Nonmydriatic
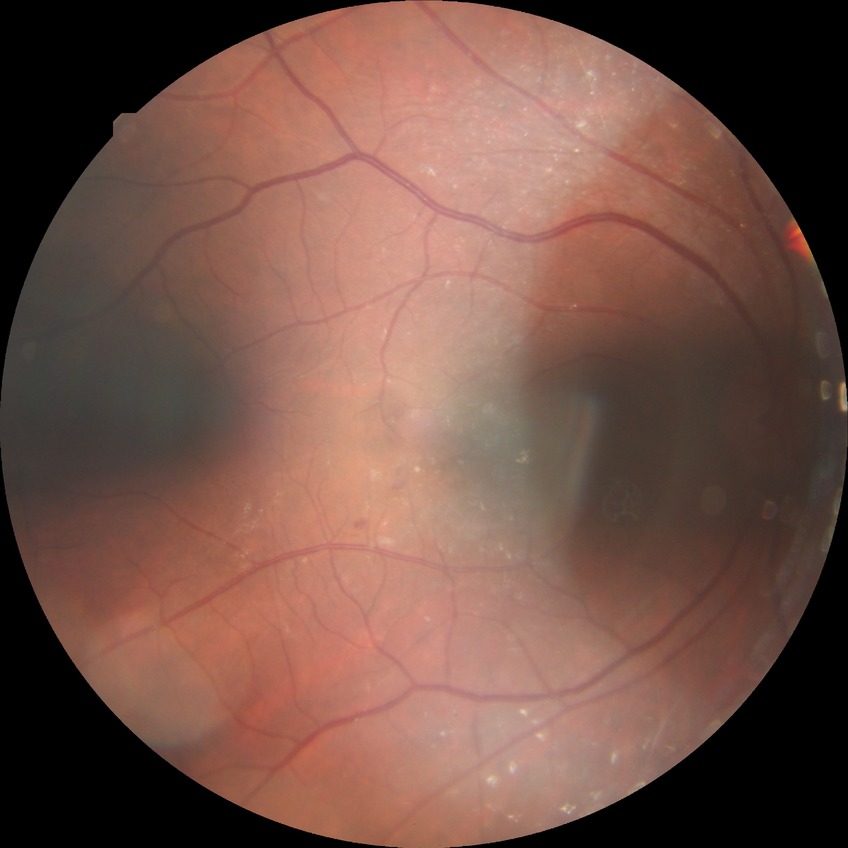

Davis stage = NDR, DR impression = no apparent DR.